2212x1661 · 30° field of view — 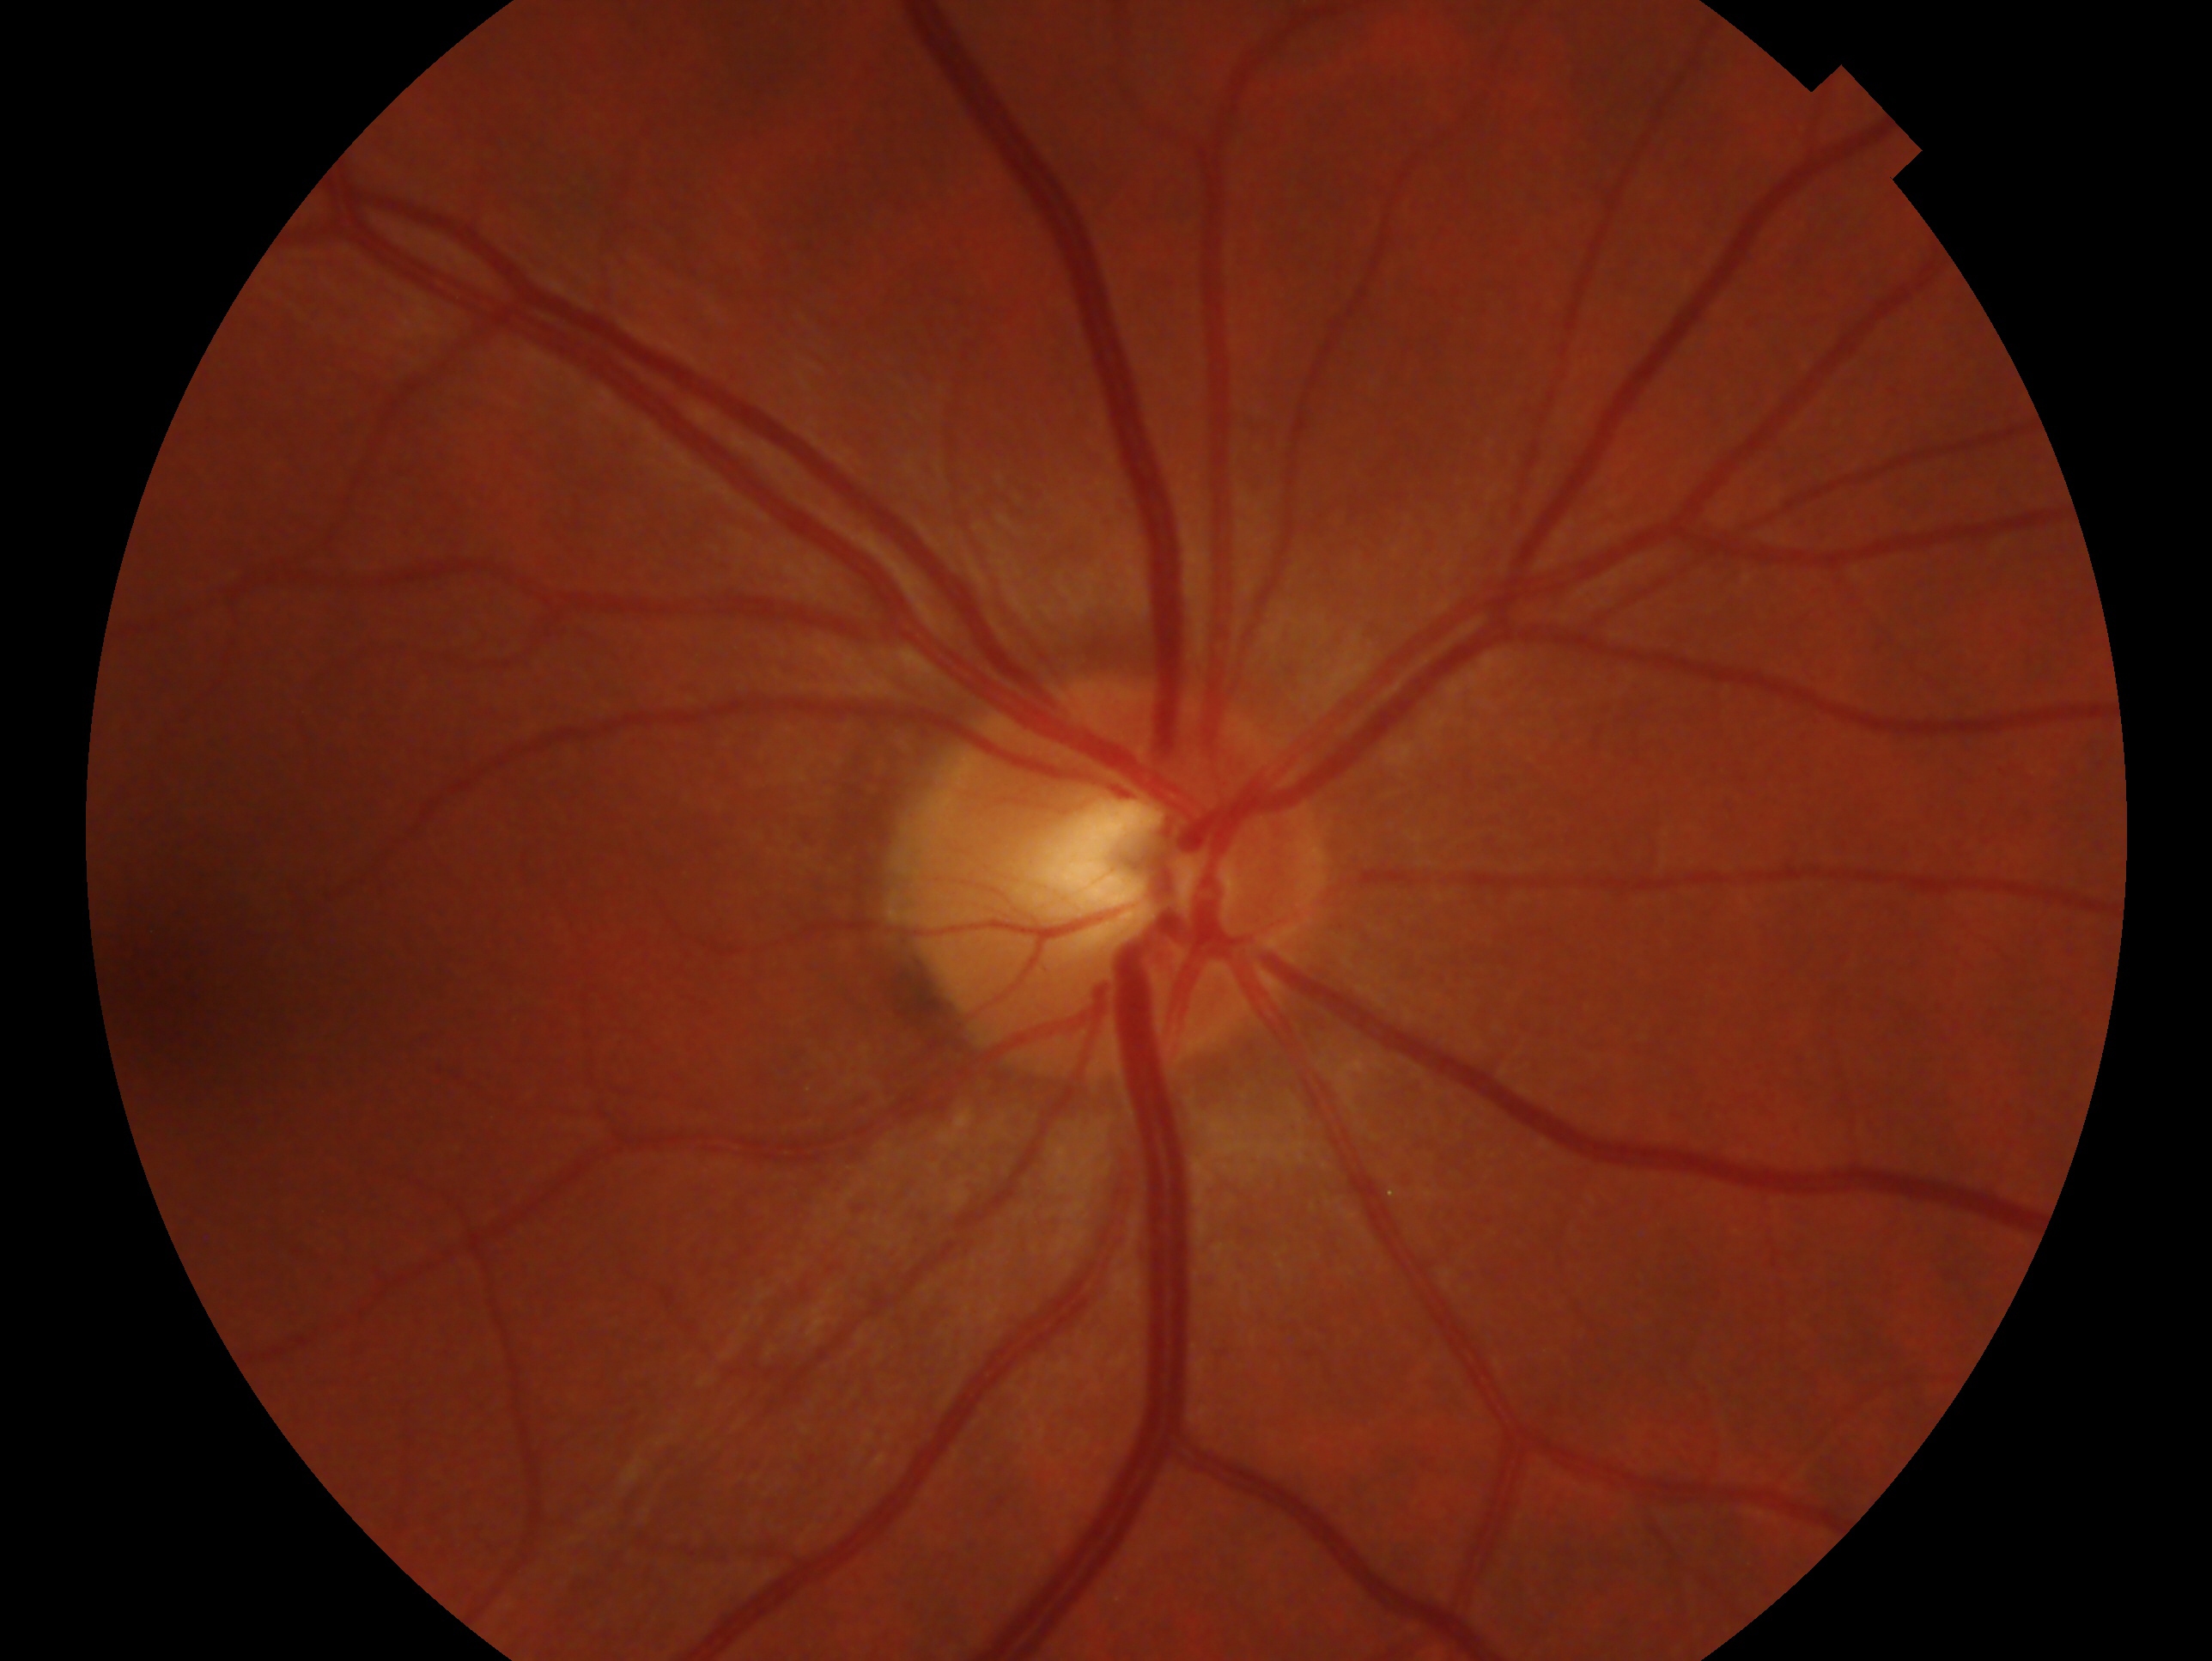

• clinical classification — no glaucomatous findings
• laterality — right eye